50 years old
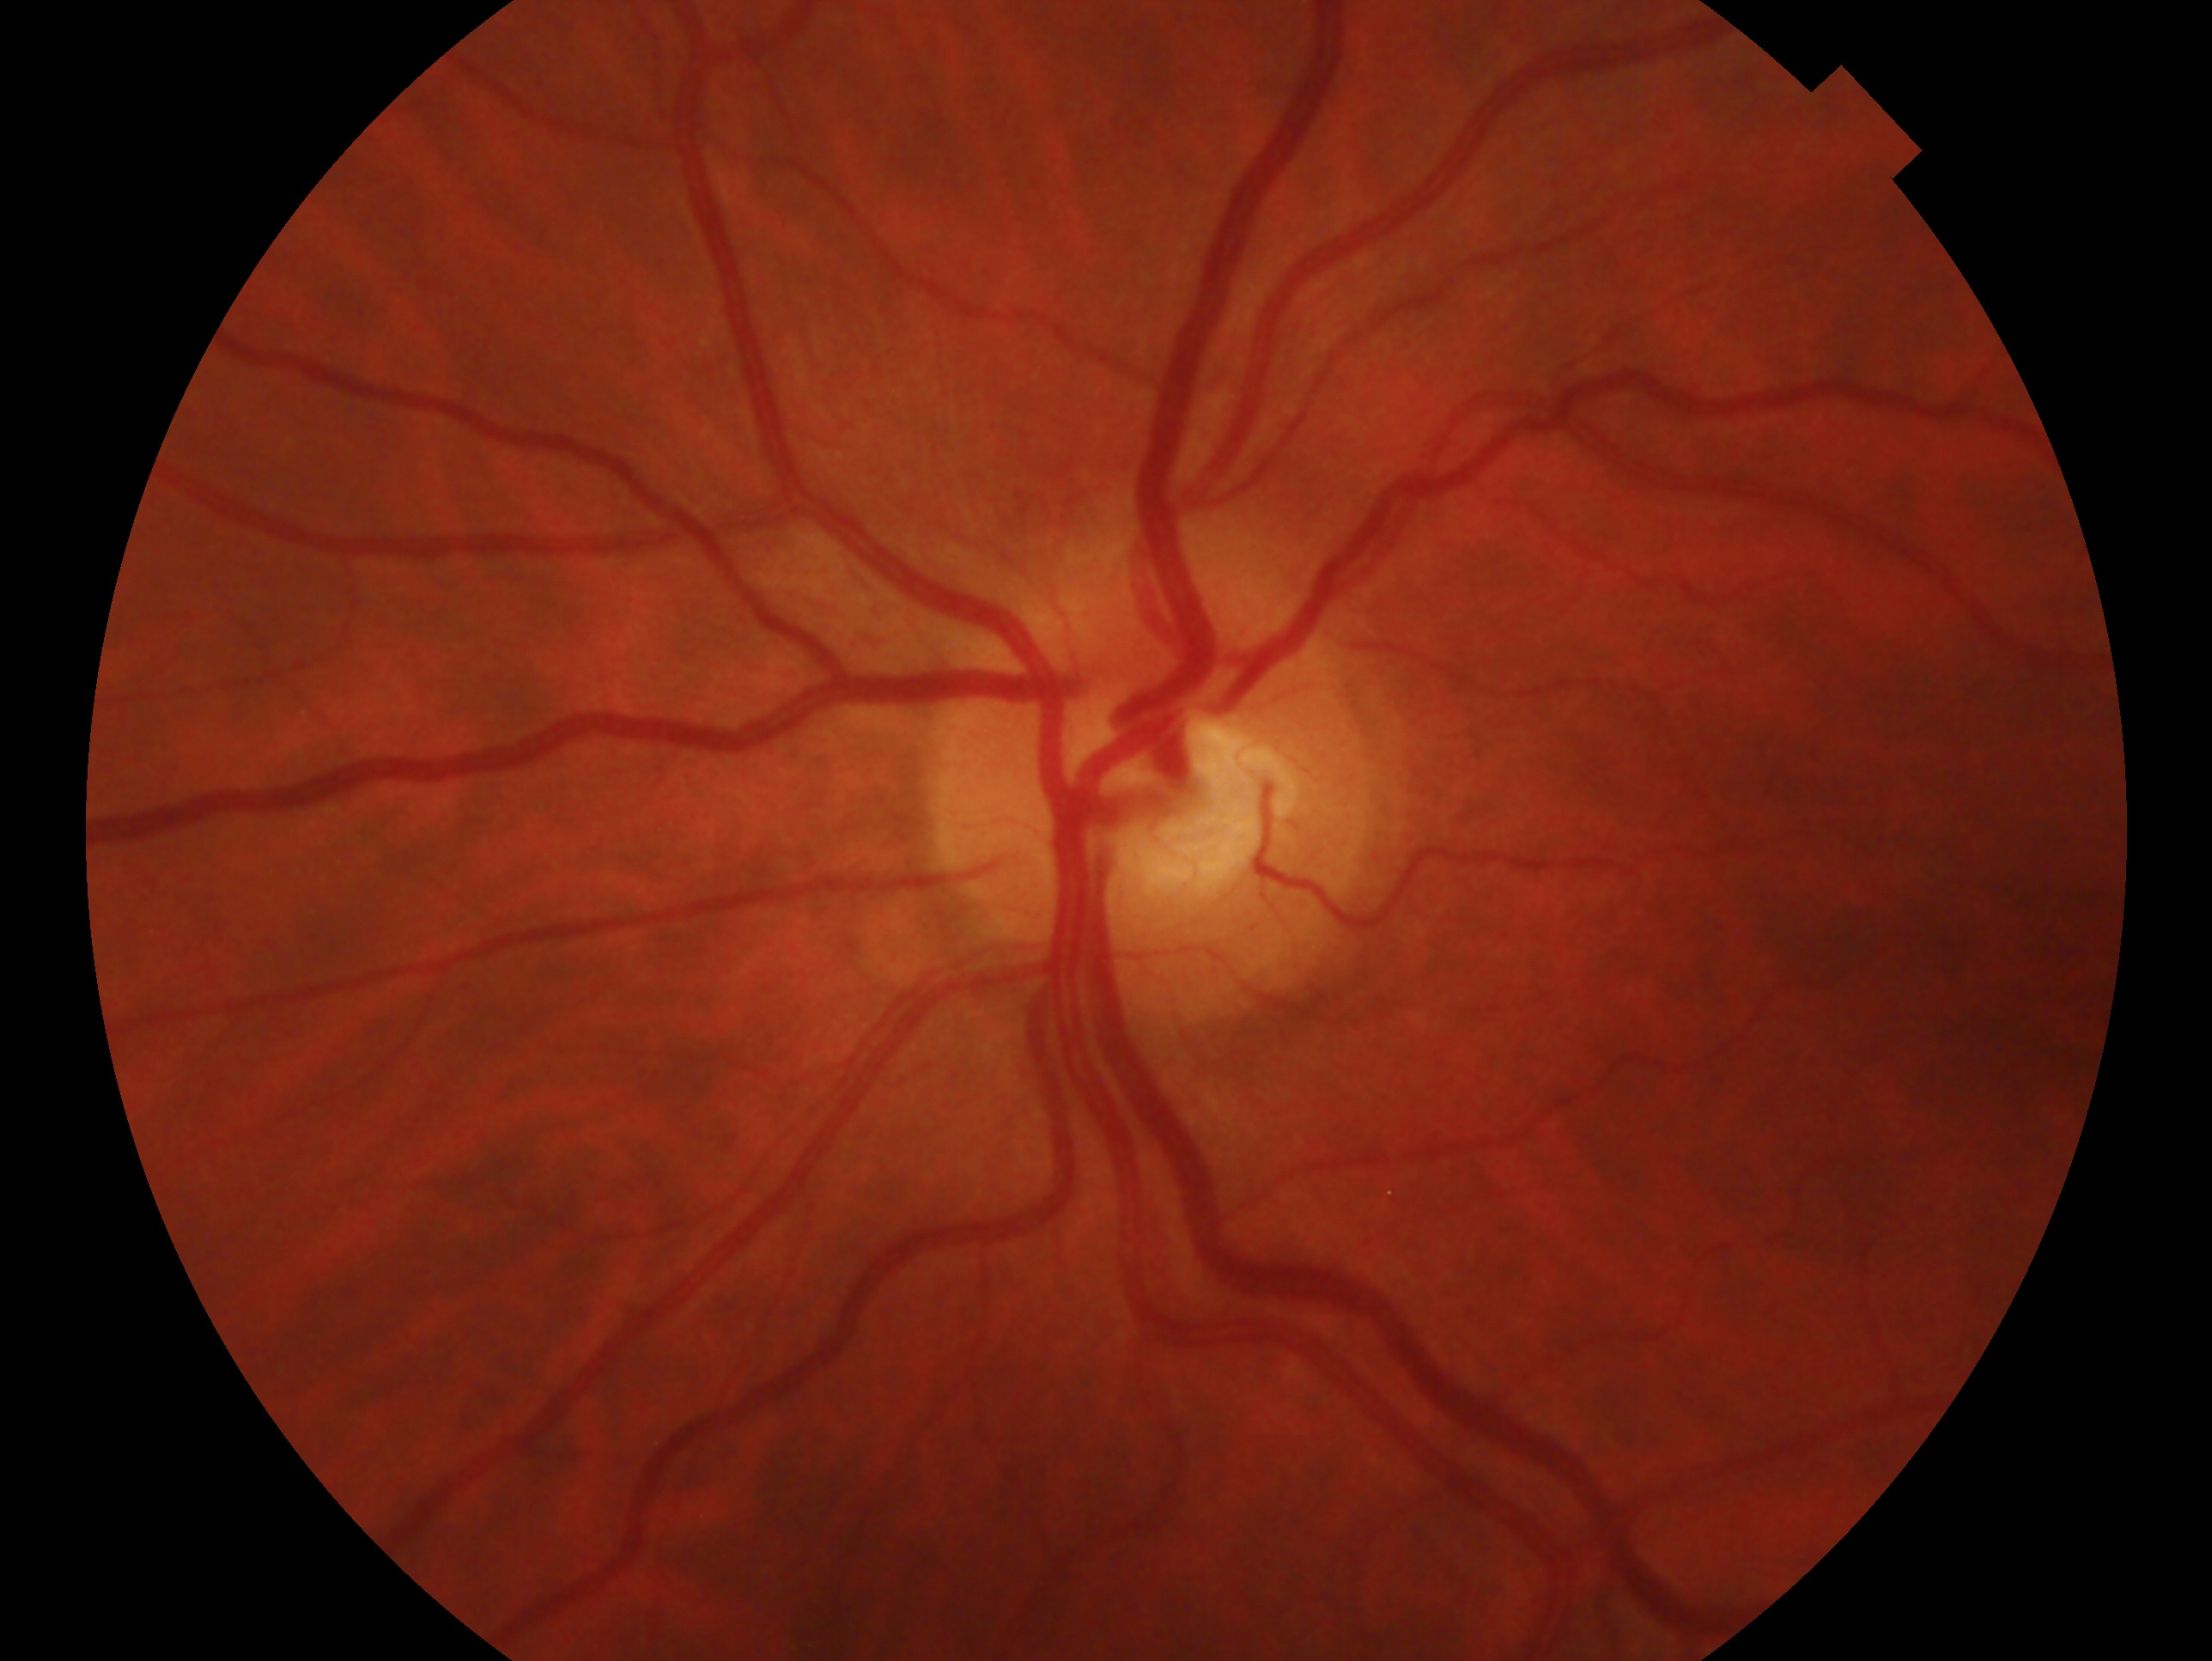 laterality: left eye
diagnosis: negative for glaucoma